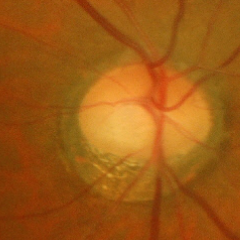 Glaucoma status: early-stage glaucoma. Defined as glaucomatous retinal nerve fiber layer defects on red-free fundus photography without visual field defects.